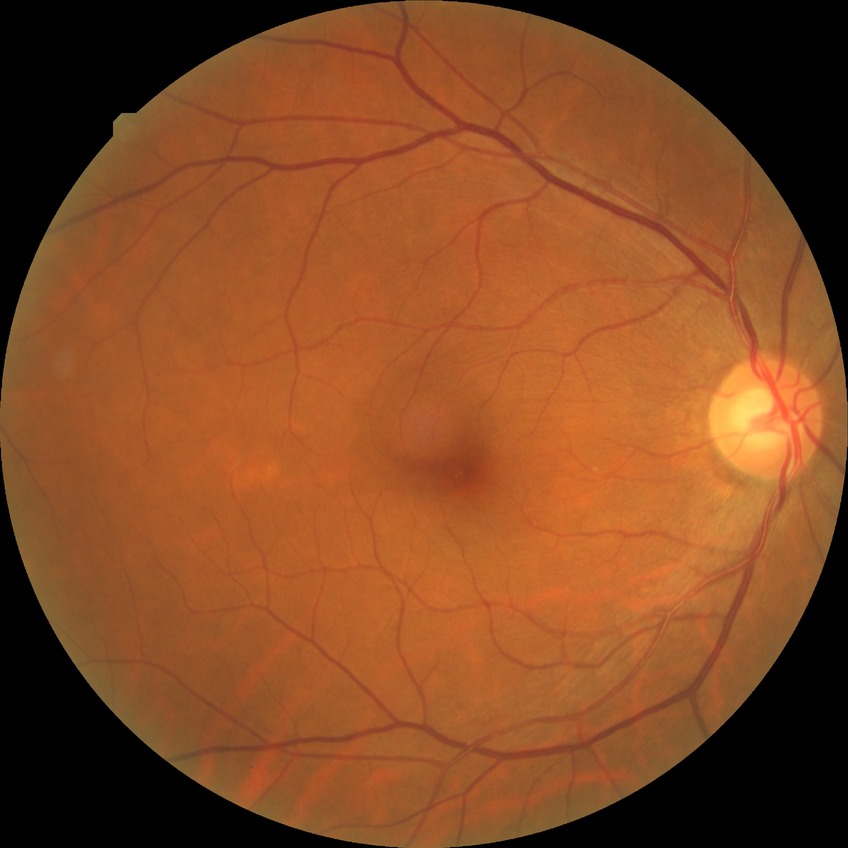
retinopathy grade@no diabetic retinopathy.